2089x1764px · fundus photo.
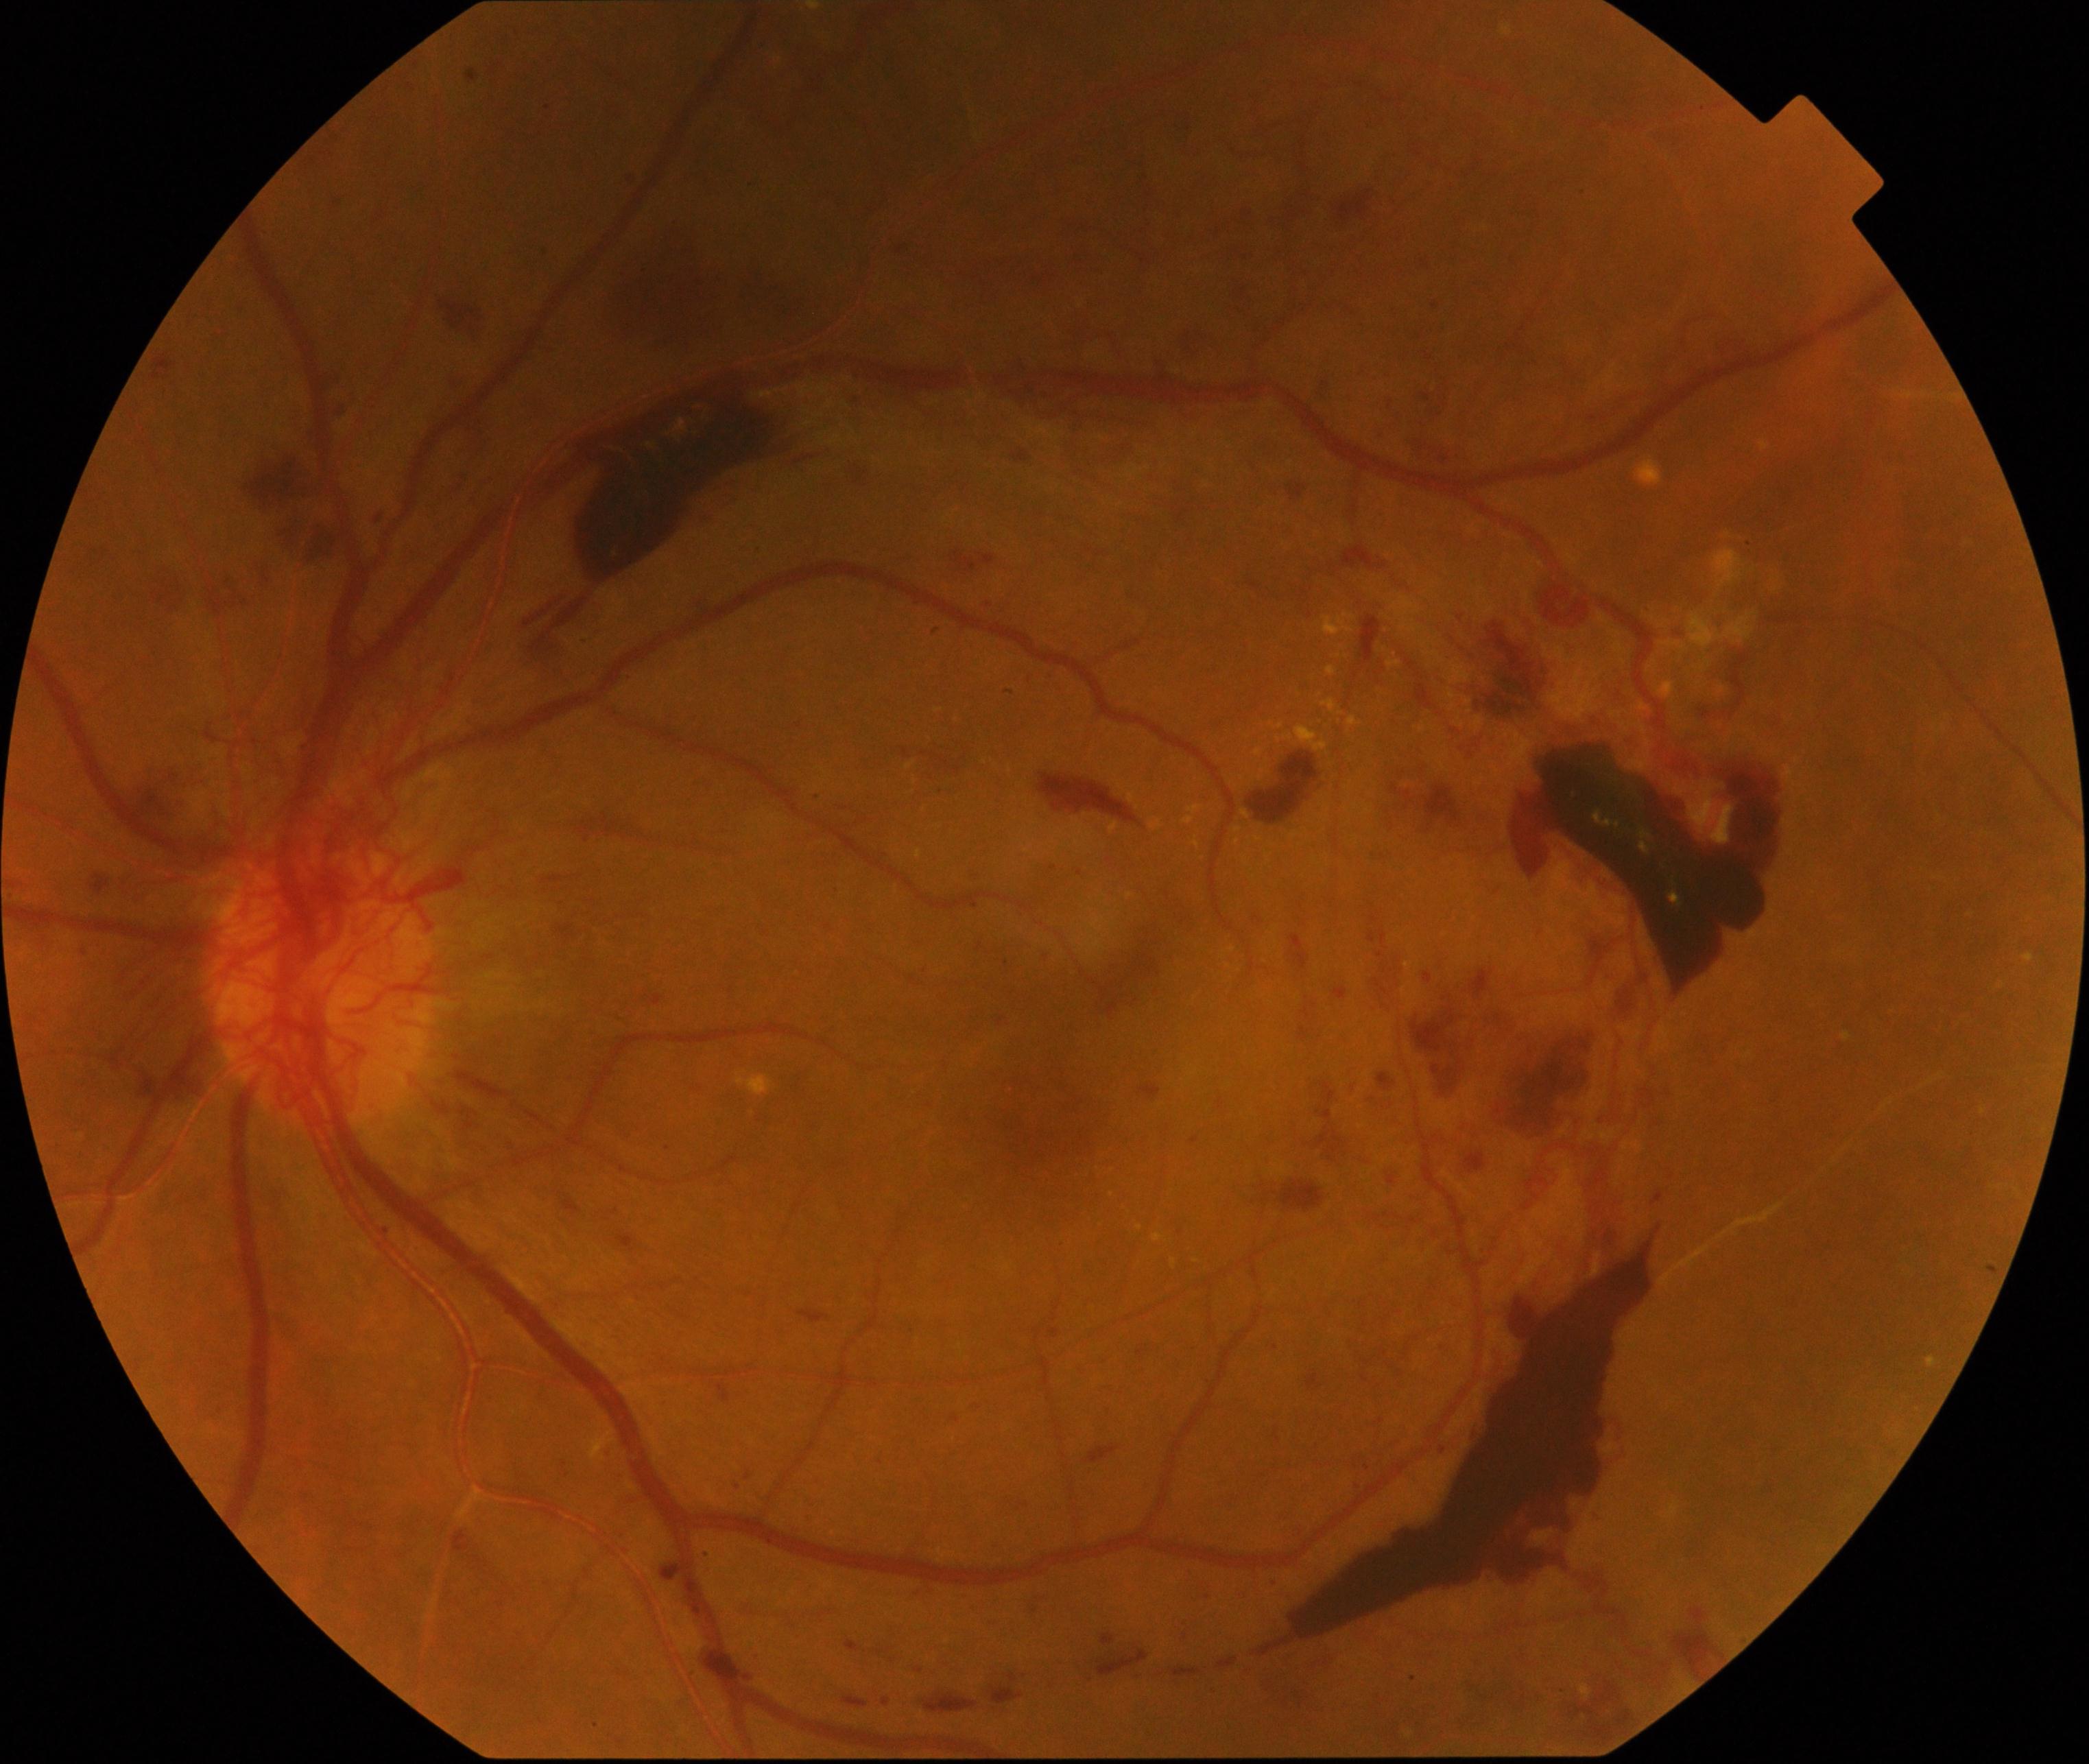
There is evidence of severe non-proliferative or proliferative diabetic retinopathy.